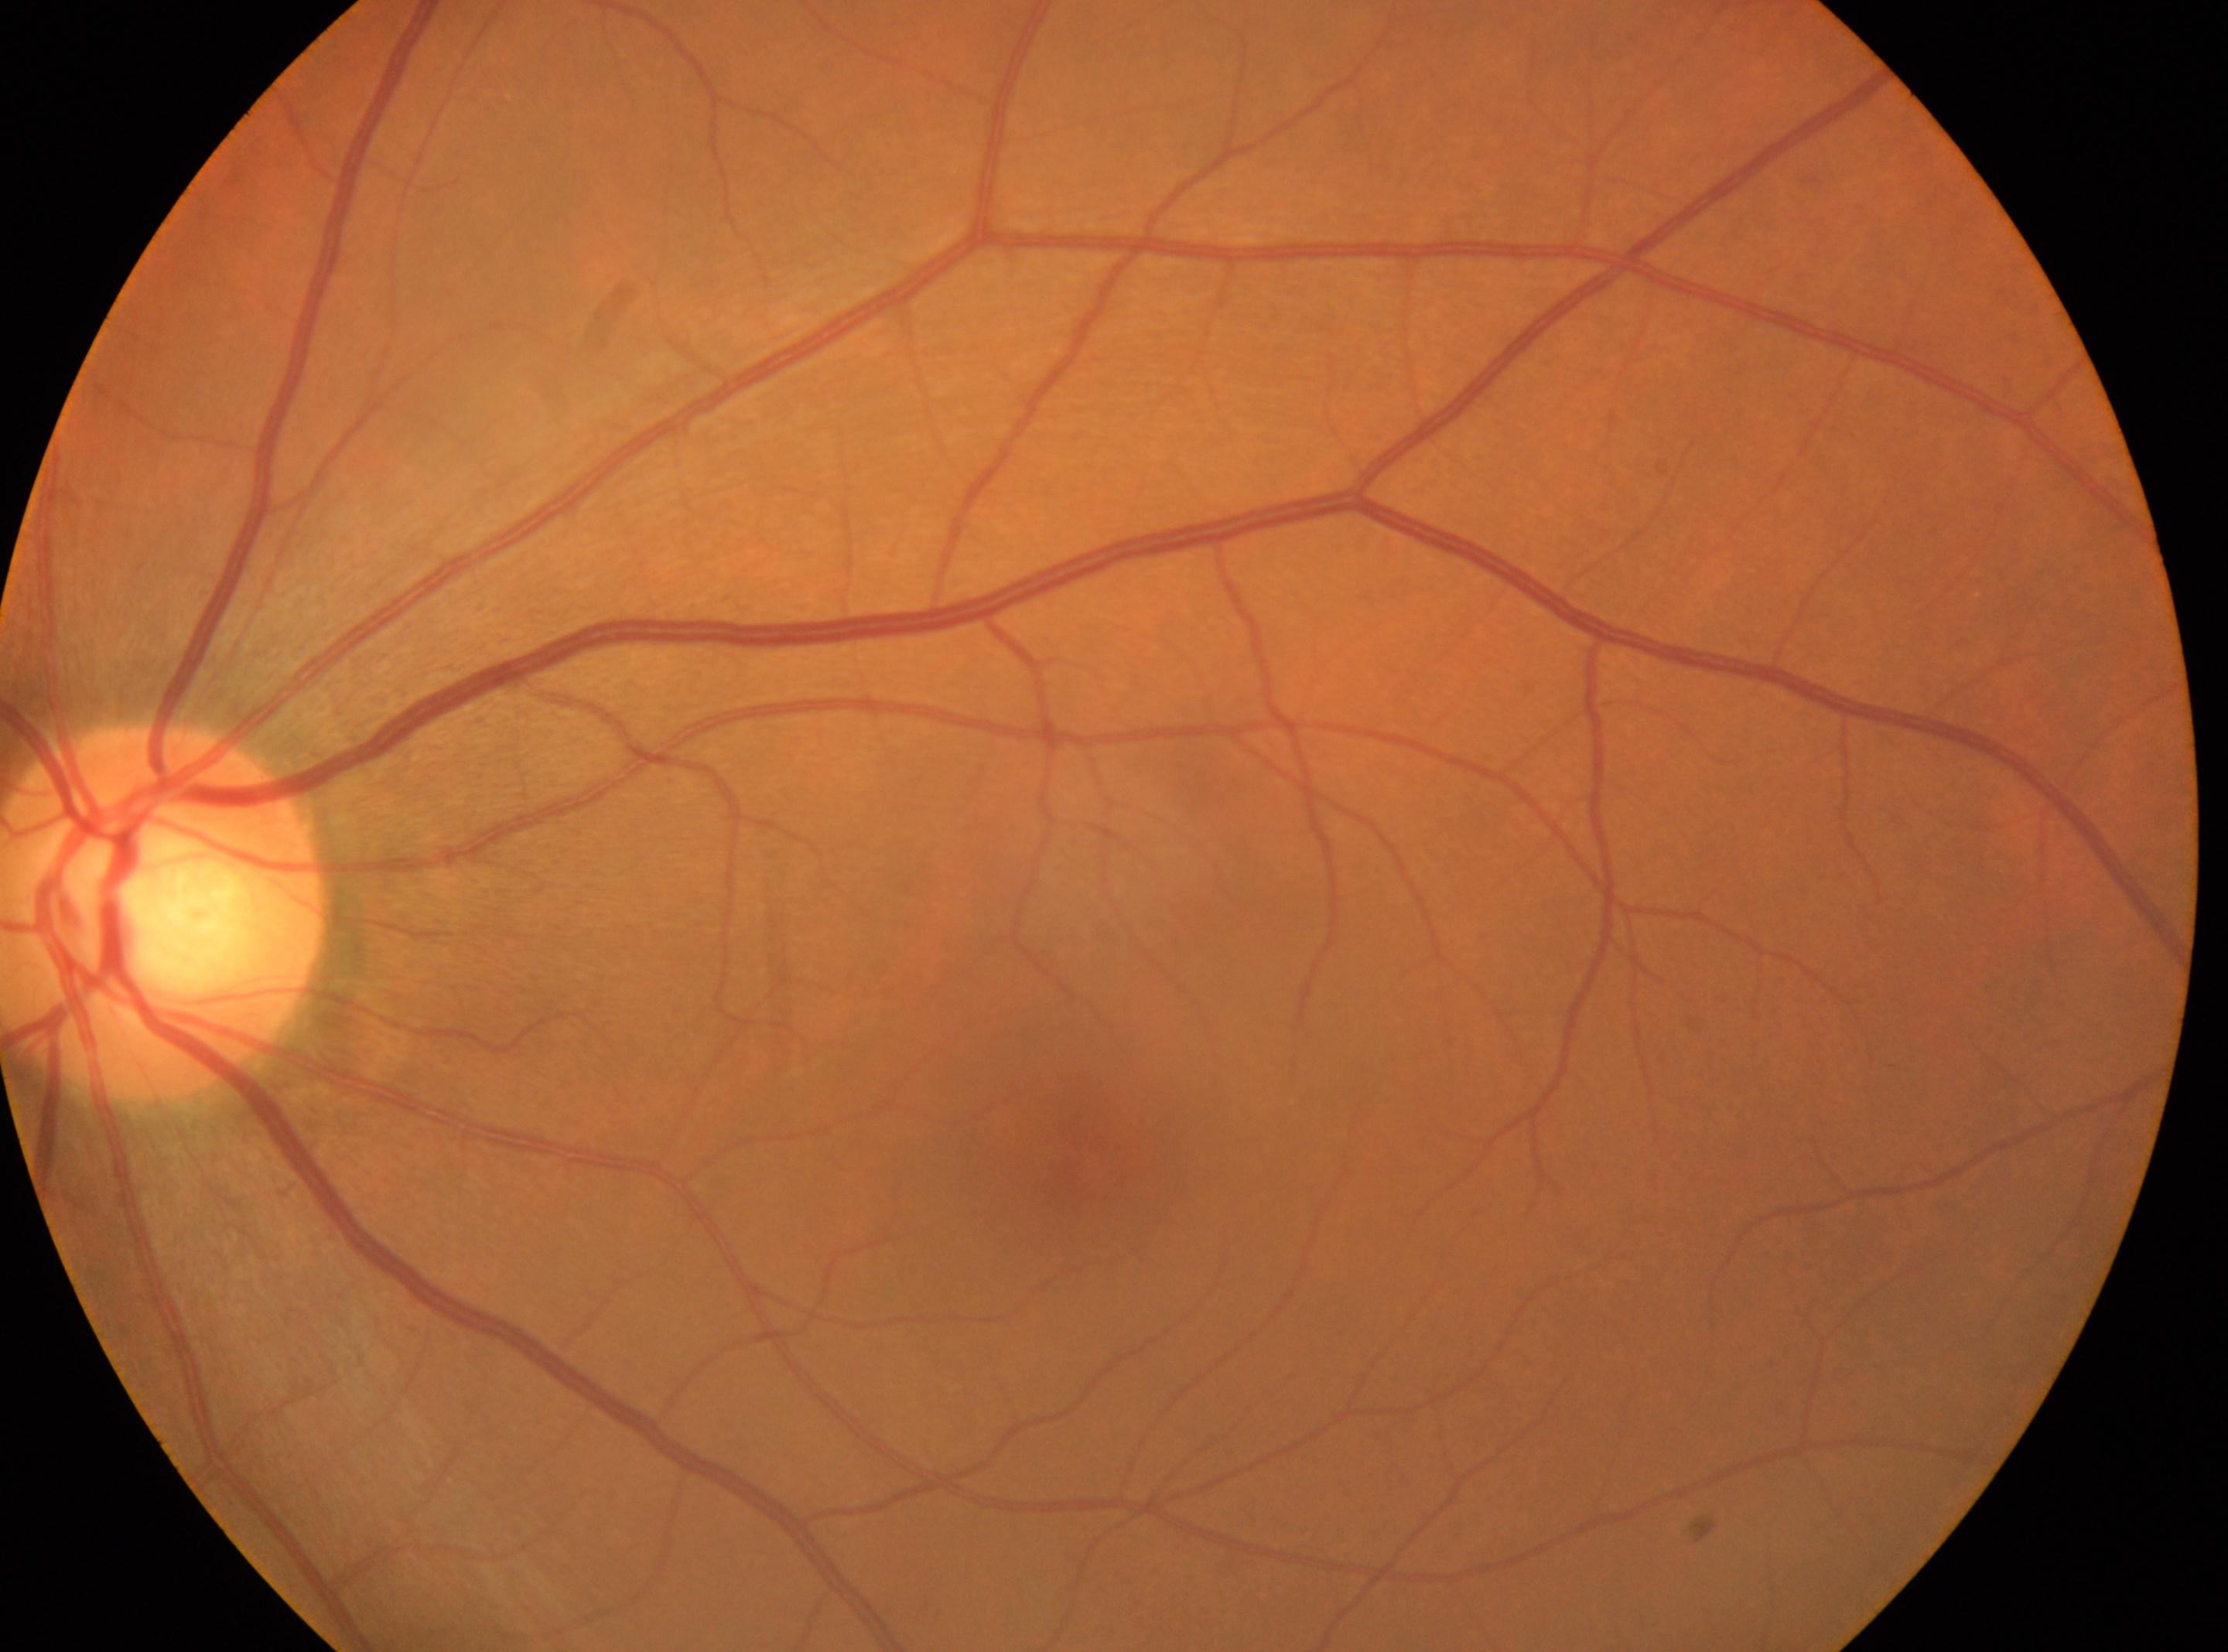

Diabetic retinopathy is grade 0 (no apparent retinopathy).
This is the left eye.
No apparent diabetic retinopathy.
The disc center is at 166, 914.
Macula center located at 1074, 1154.